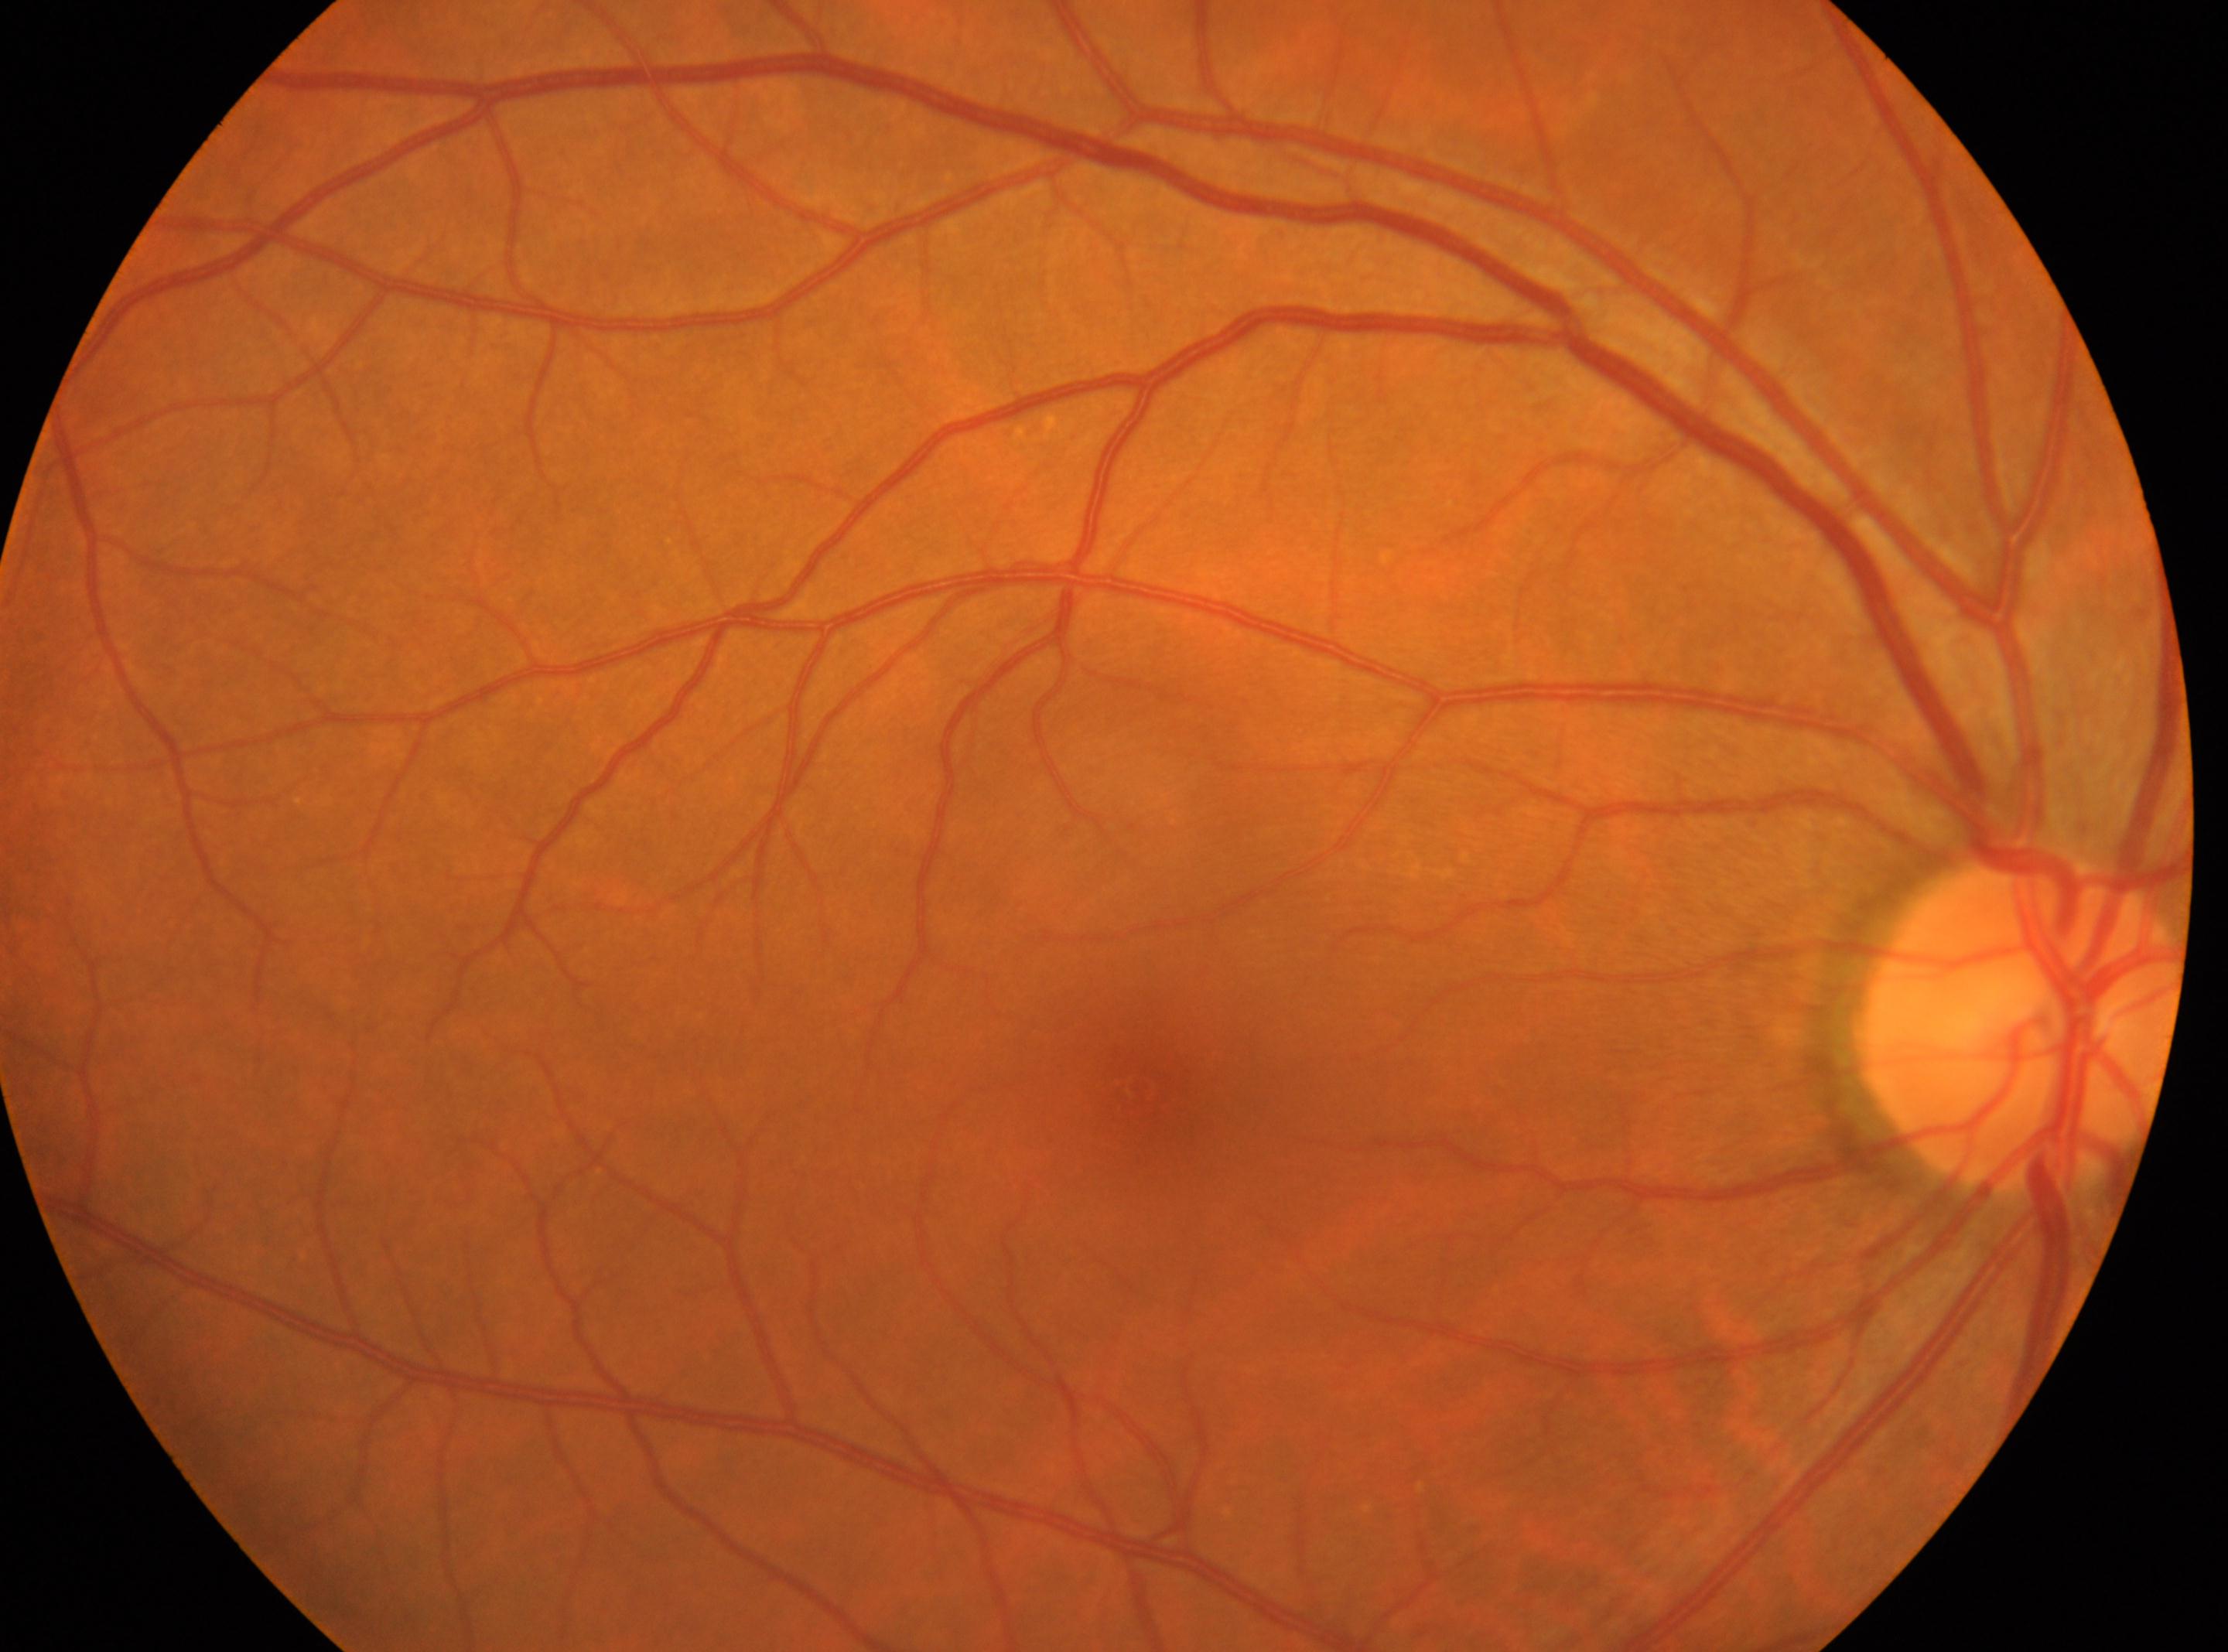 Findings:
• foveal center — x=1136, y=1084
• optic disc center — x=2019, y=1016
• DR stage — 0 — no visible signs of diabetic retinopathy
• eye — OD